Infant wide-field retinal image: 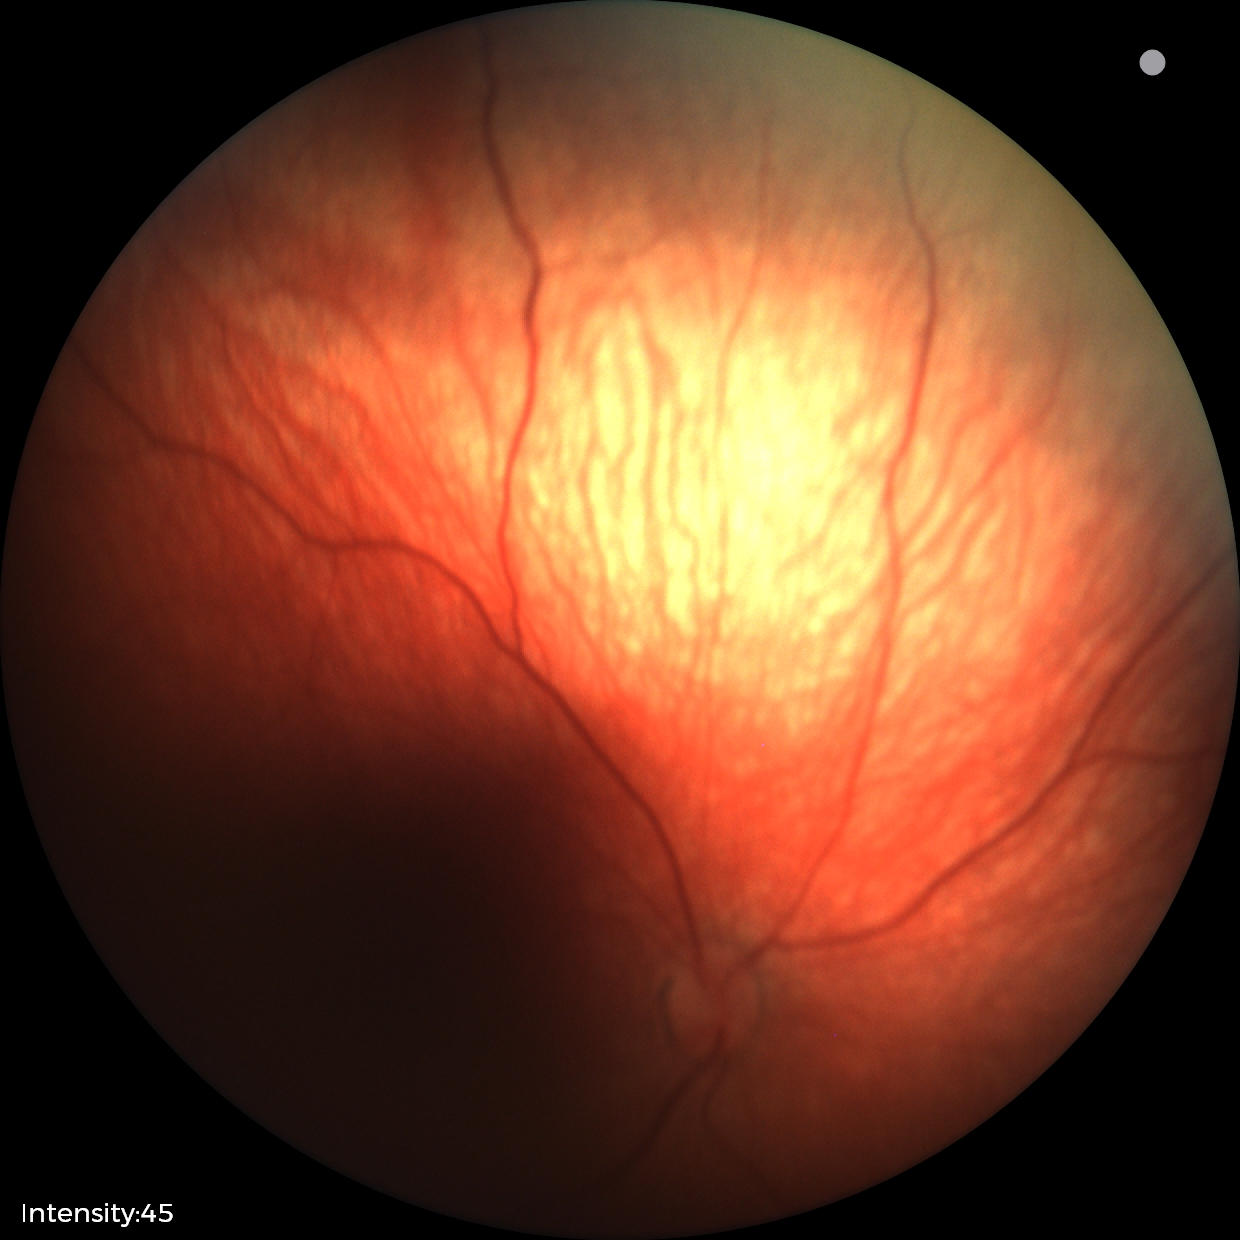 Screening examination diagnosed as physiological.